Infant wide-field retinal image. 1240x1240:
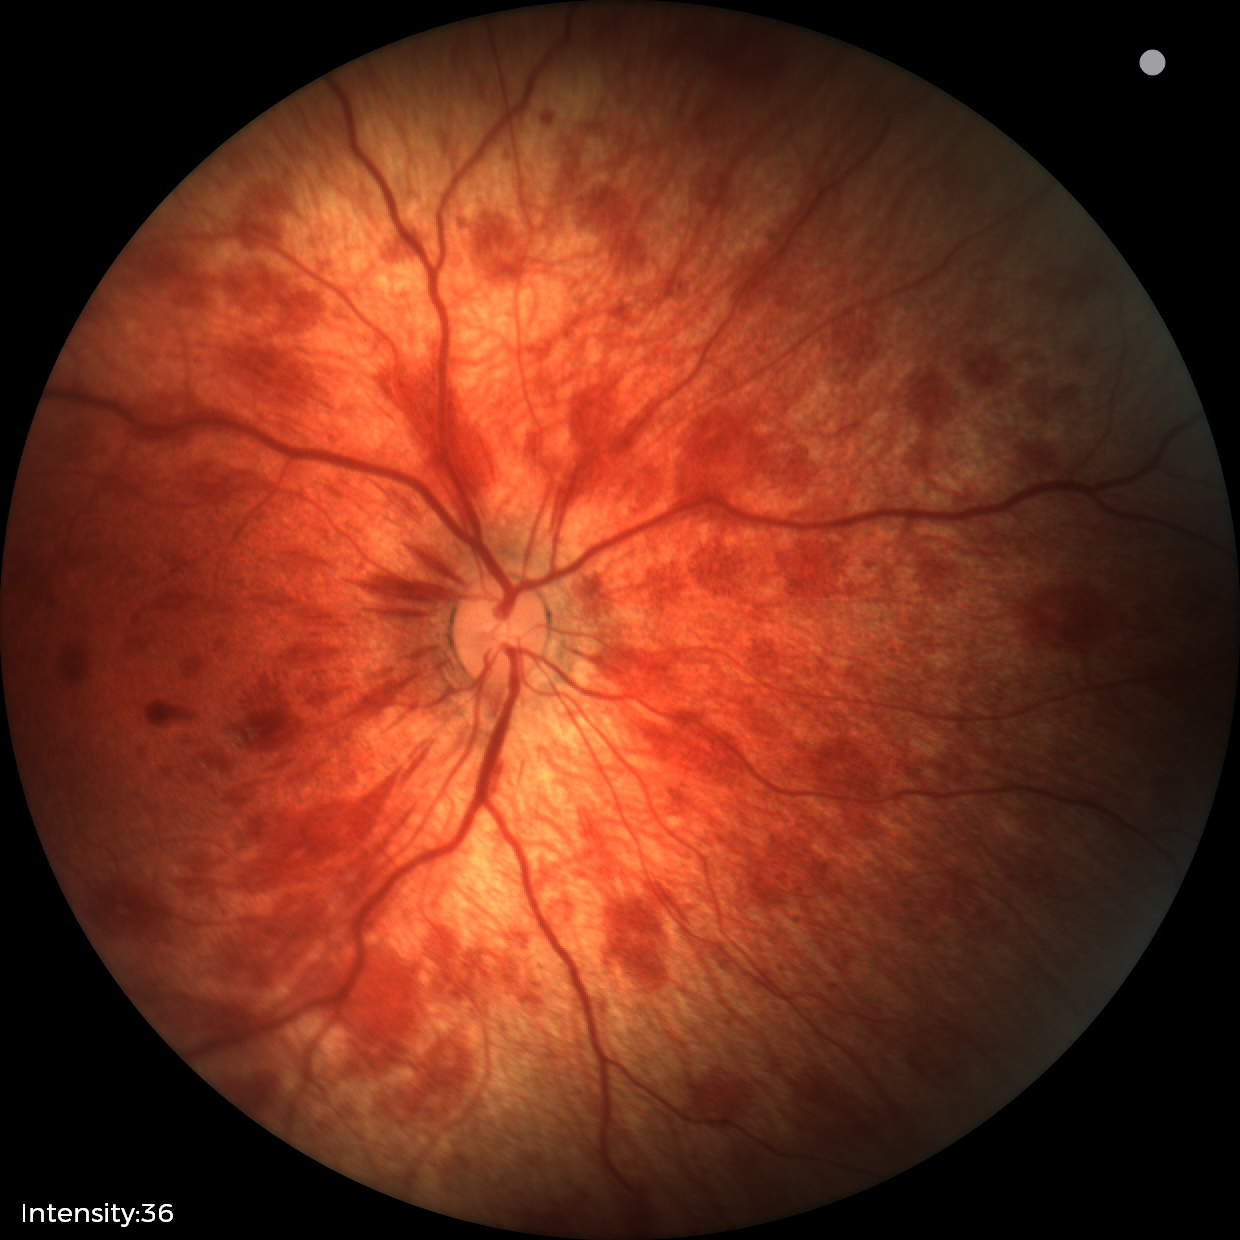
From an examination with diagnosis of retinal hemorrhages.